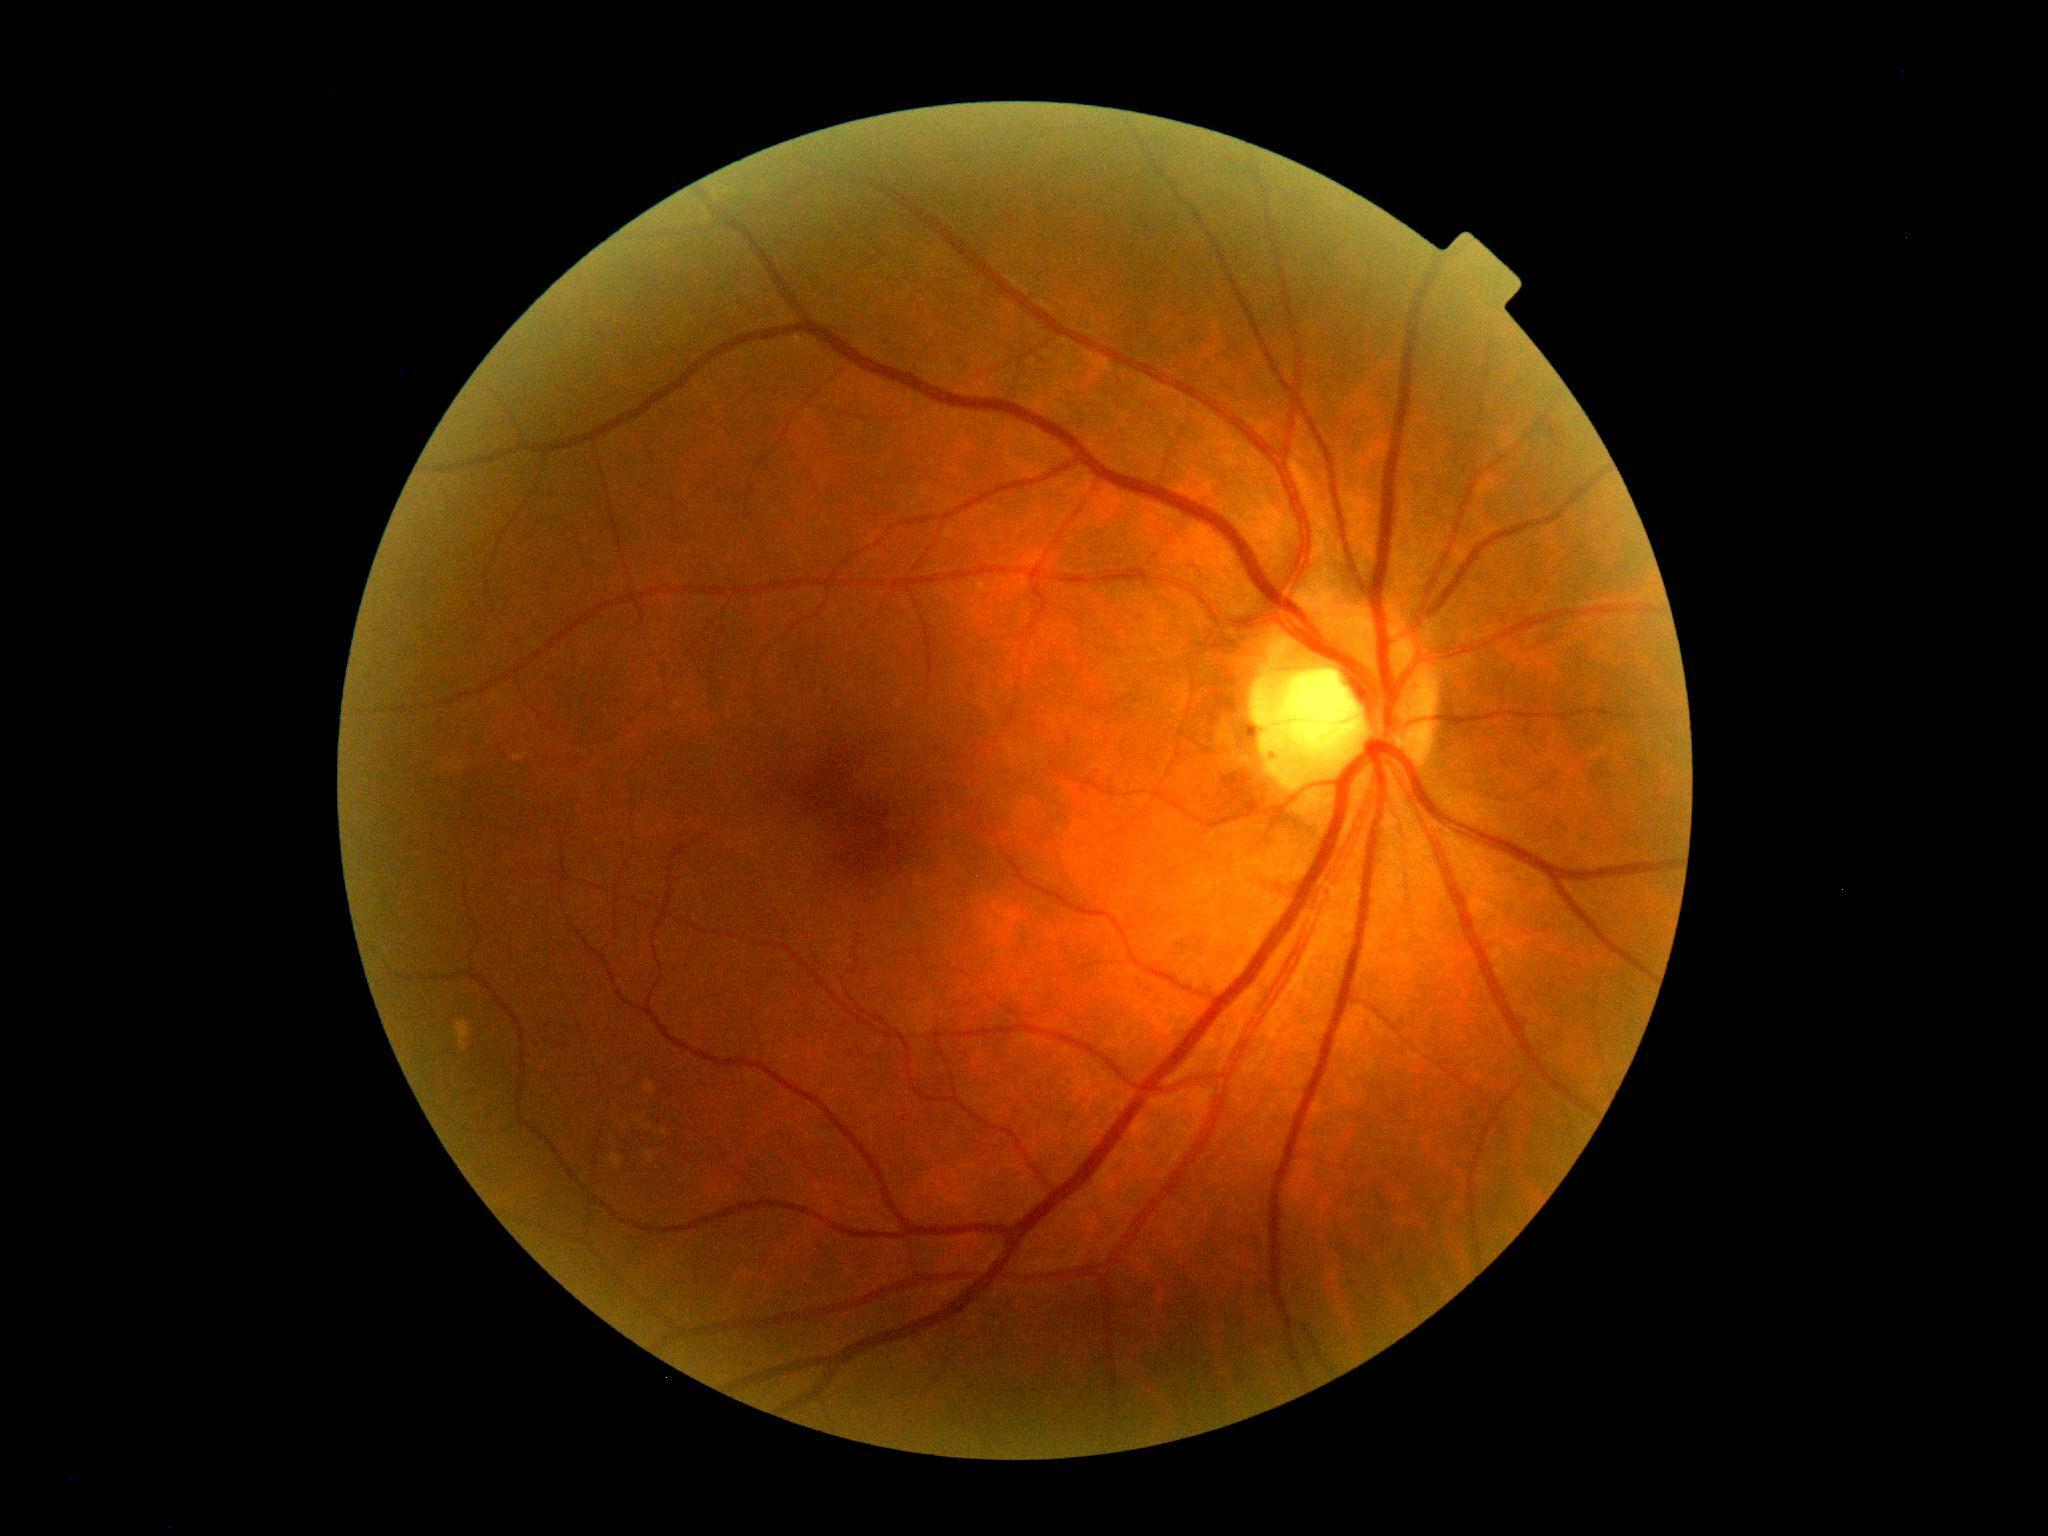
  dr_impression: no DR findings
  dr_grade: 0/4